CFP
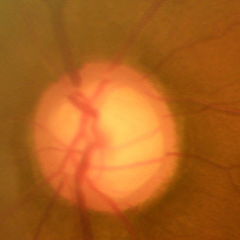

Findings consistent with early glaucomatous optic neuropathy. Diagnostic criteria: glaucomatous retinal nerve fiber layer defects on red-free fundus photography without visual field defects.